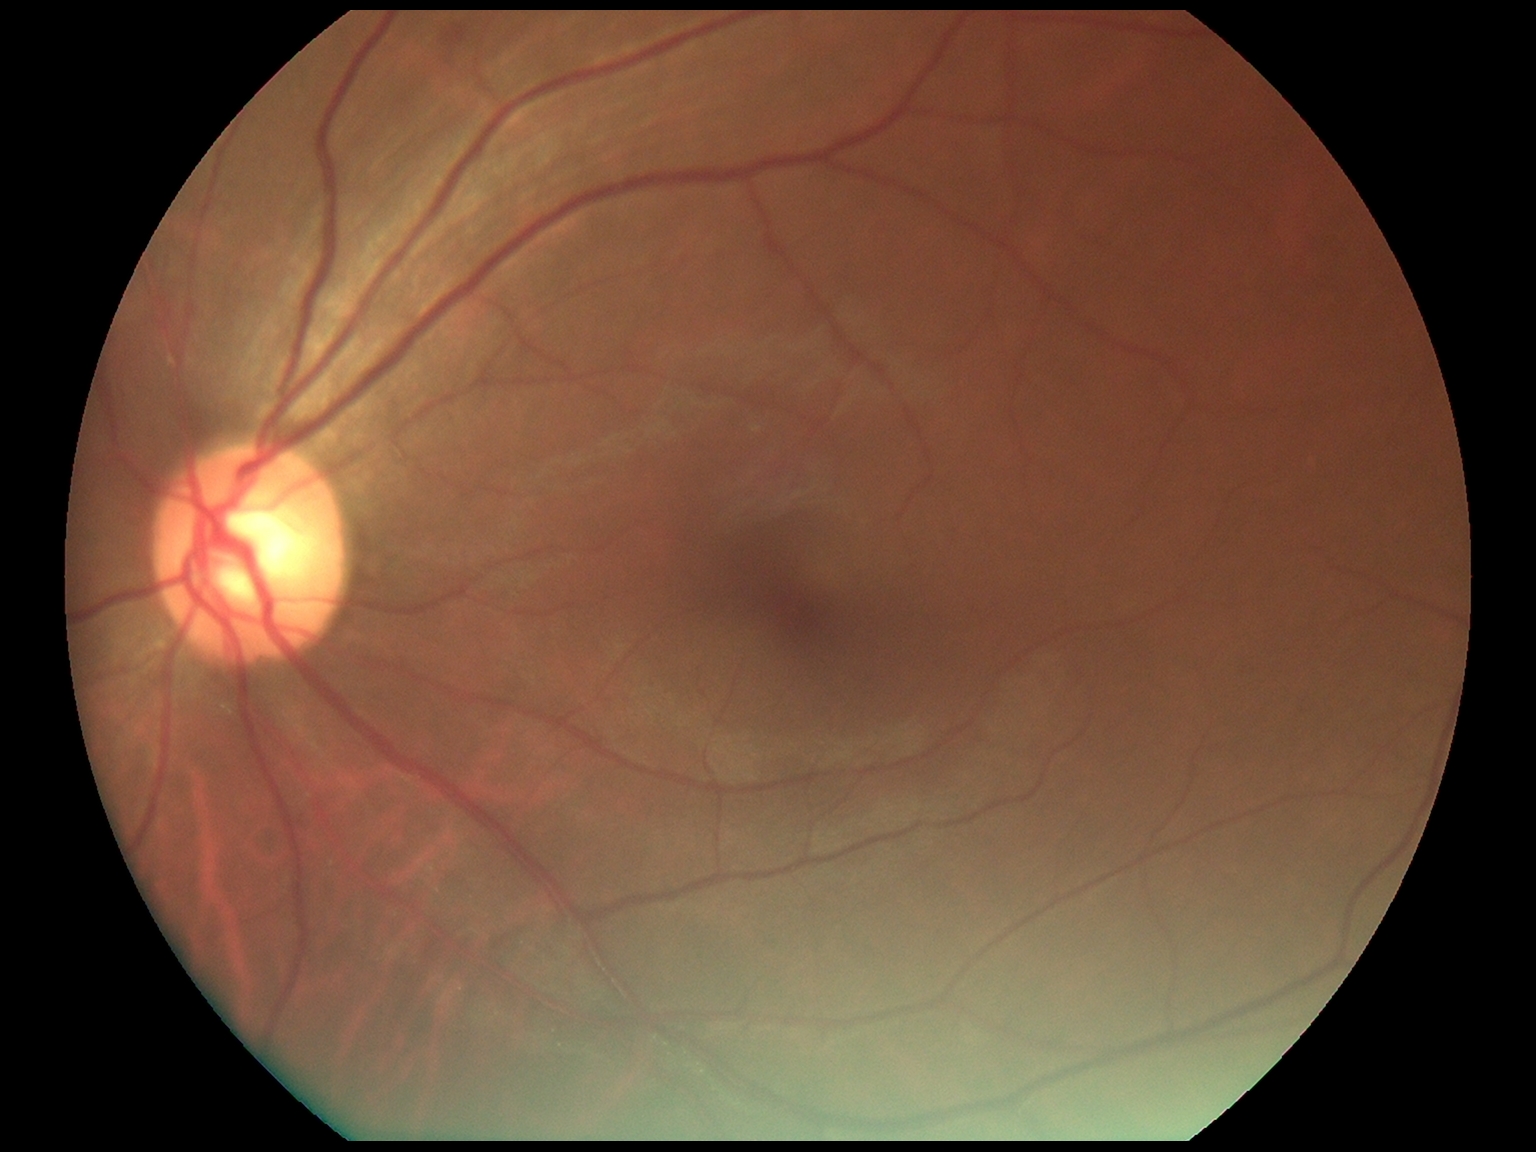

DR stage: 2 — more than just microaneurysms but less than severe NPDR